2212 x 1659 pixels — 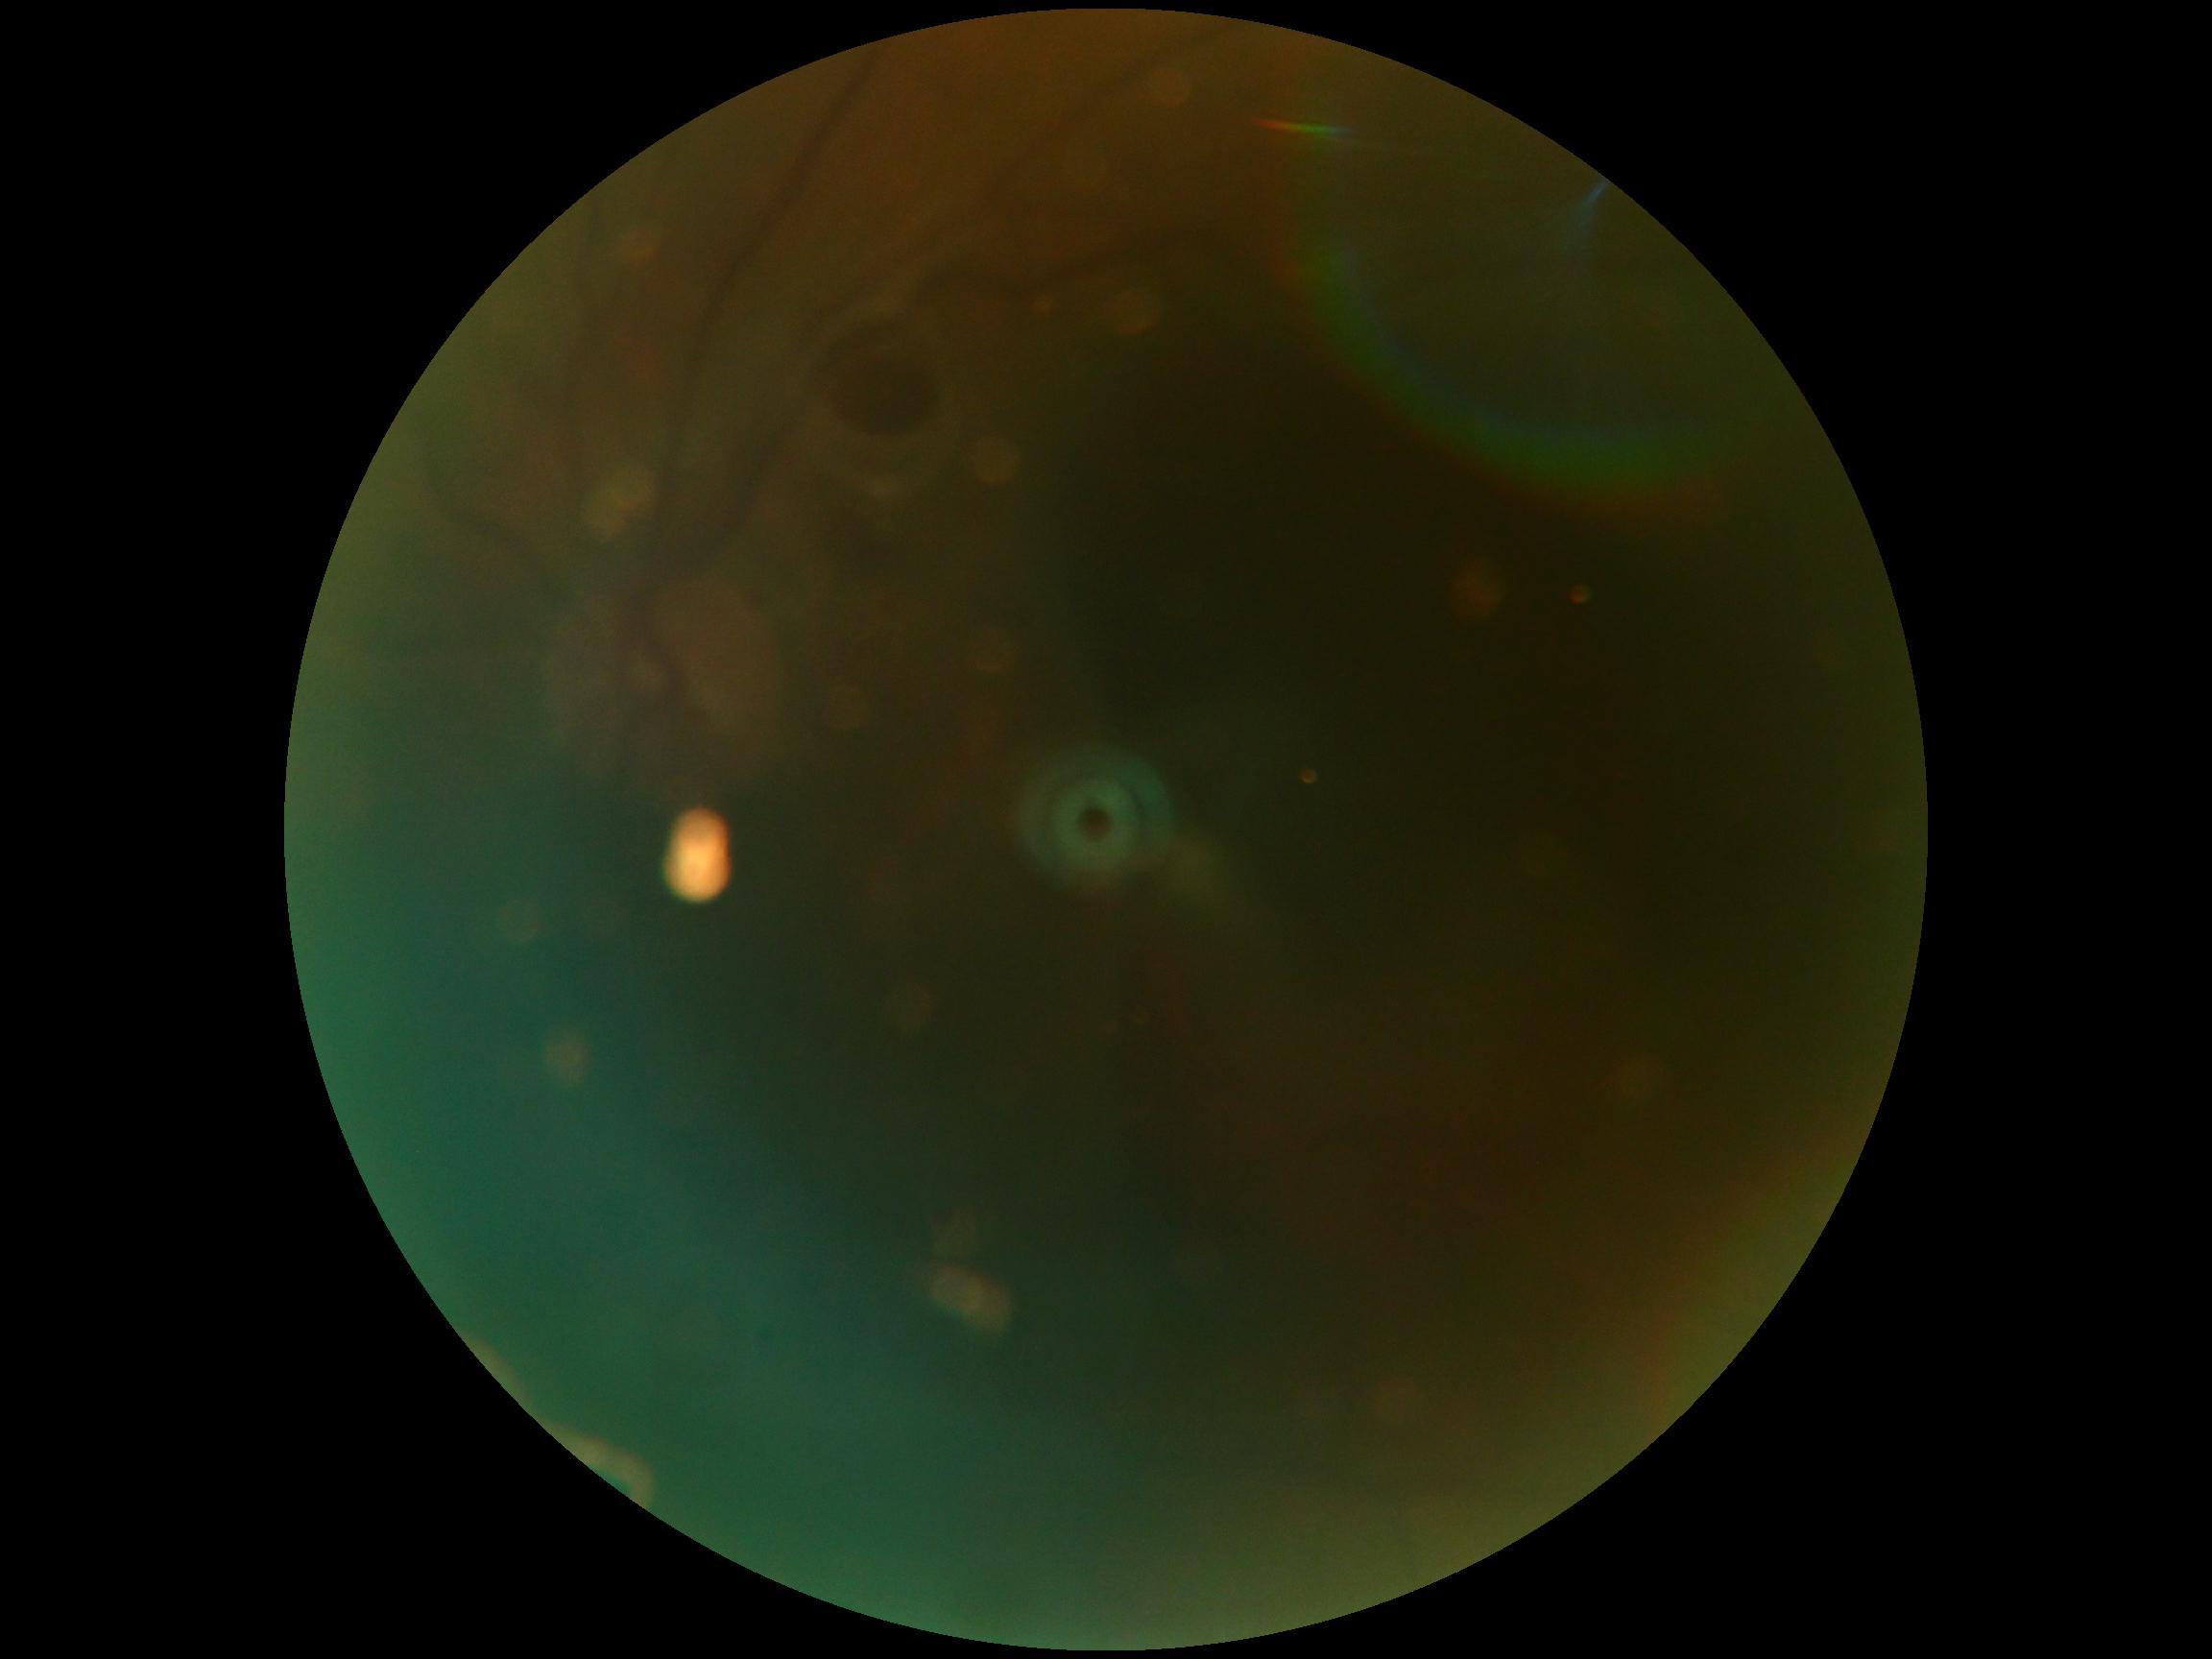

Retinopathy grade is ungradable due to poor image quality.
Image quality is insufficient for diabetic retinopathy assessment.